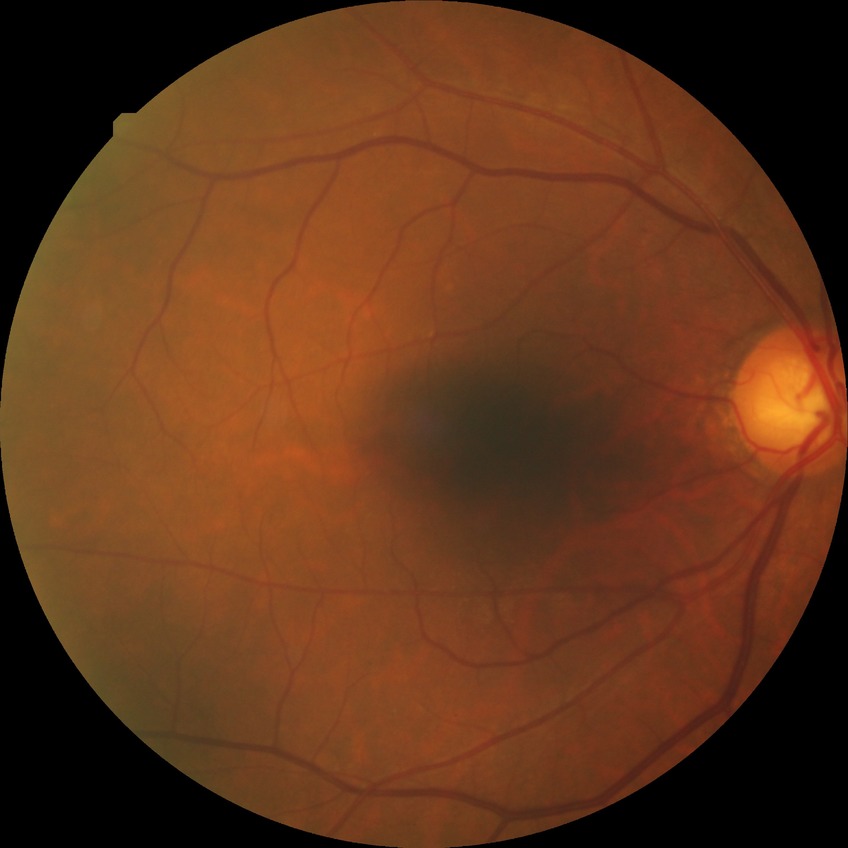

DR severity = SDR.